Clarity RetCam 3, 130° FOV; RetCam wide-field infant fundus image — 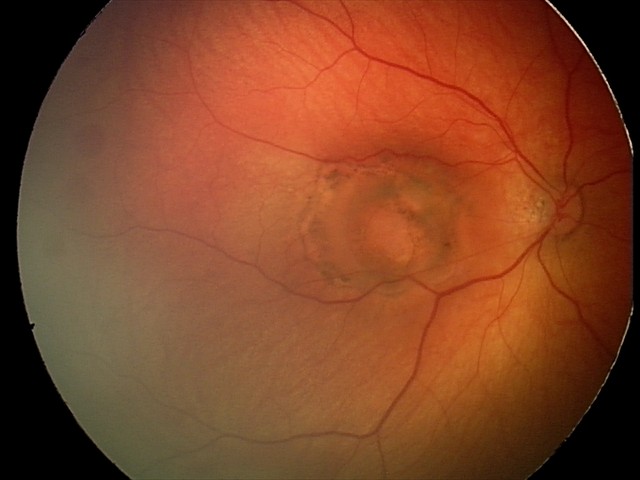 Q: What was the screening finding?
A: toxoplasmosis chorioretinitis